45-degree field of view. 2352x1568
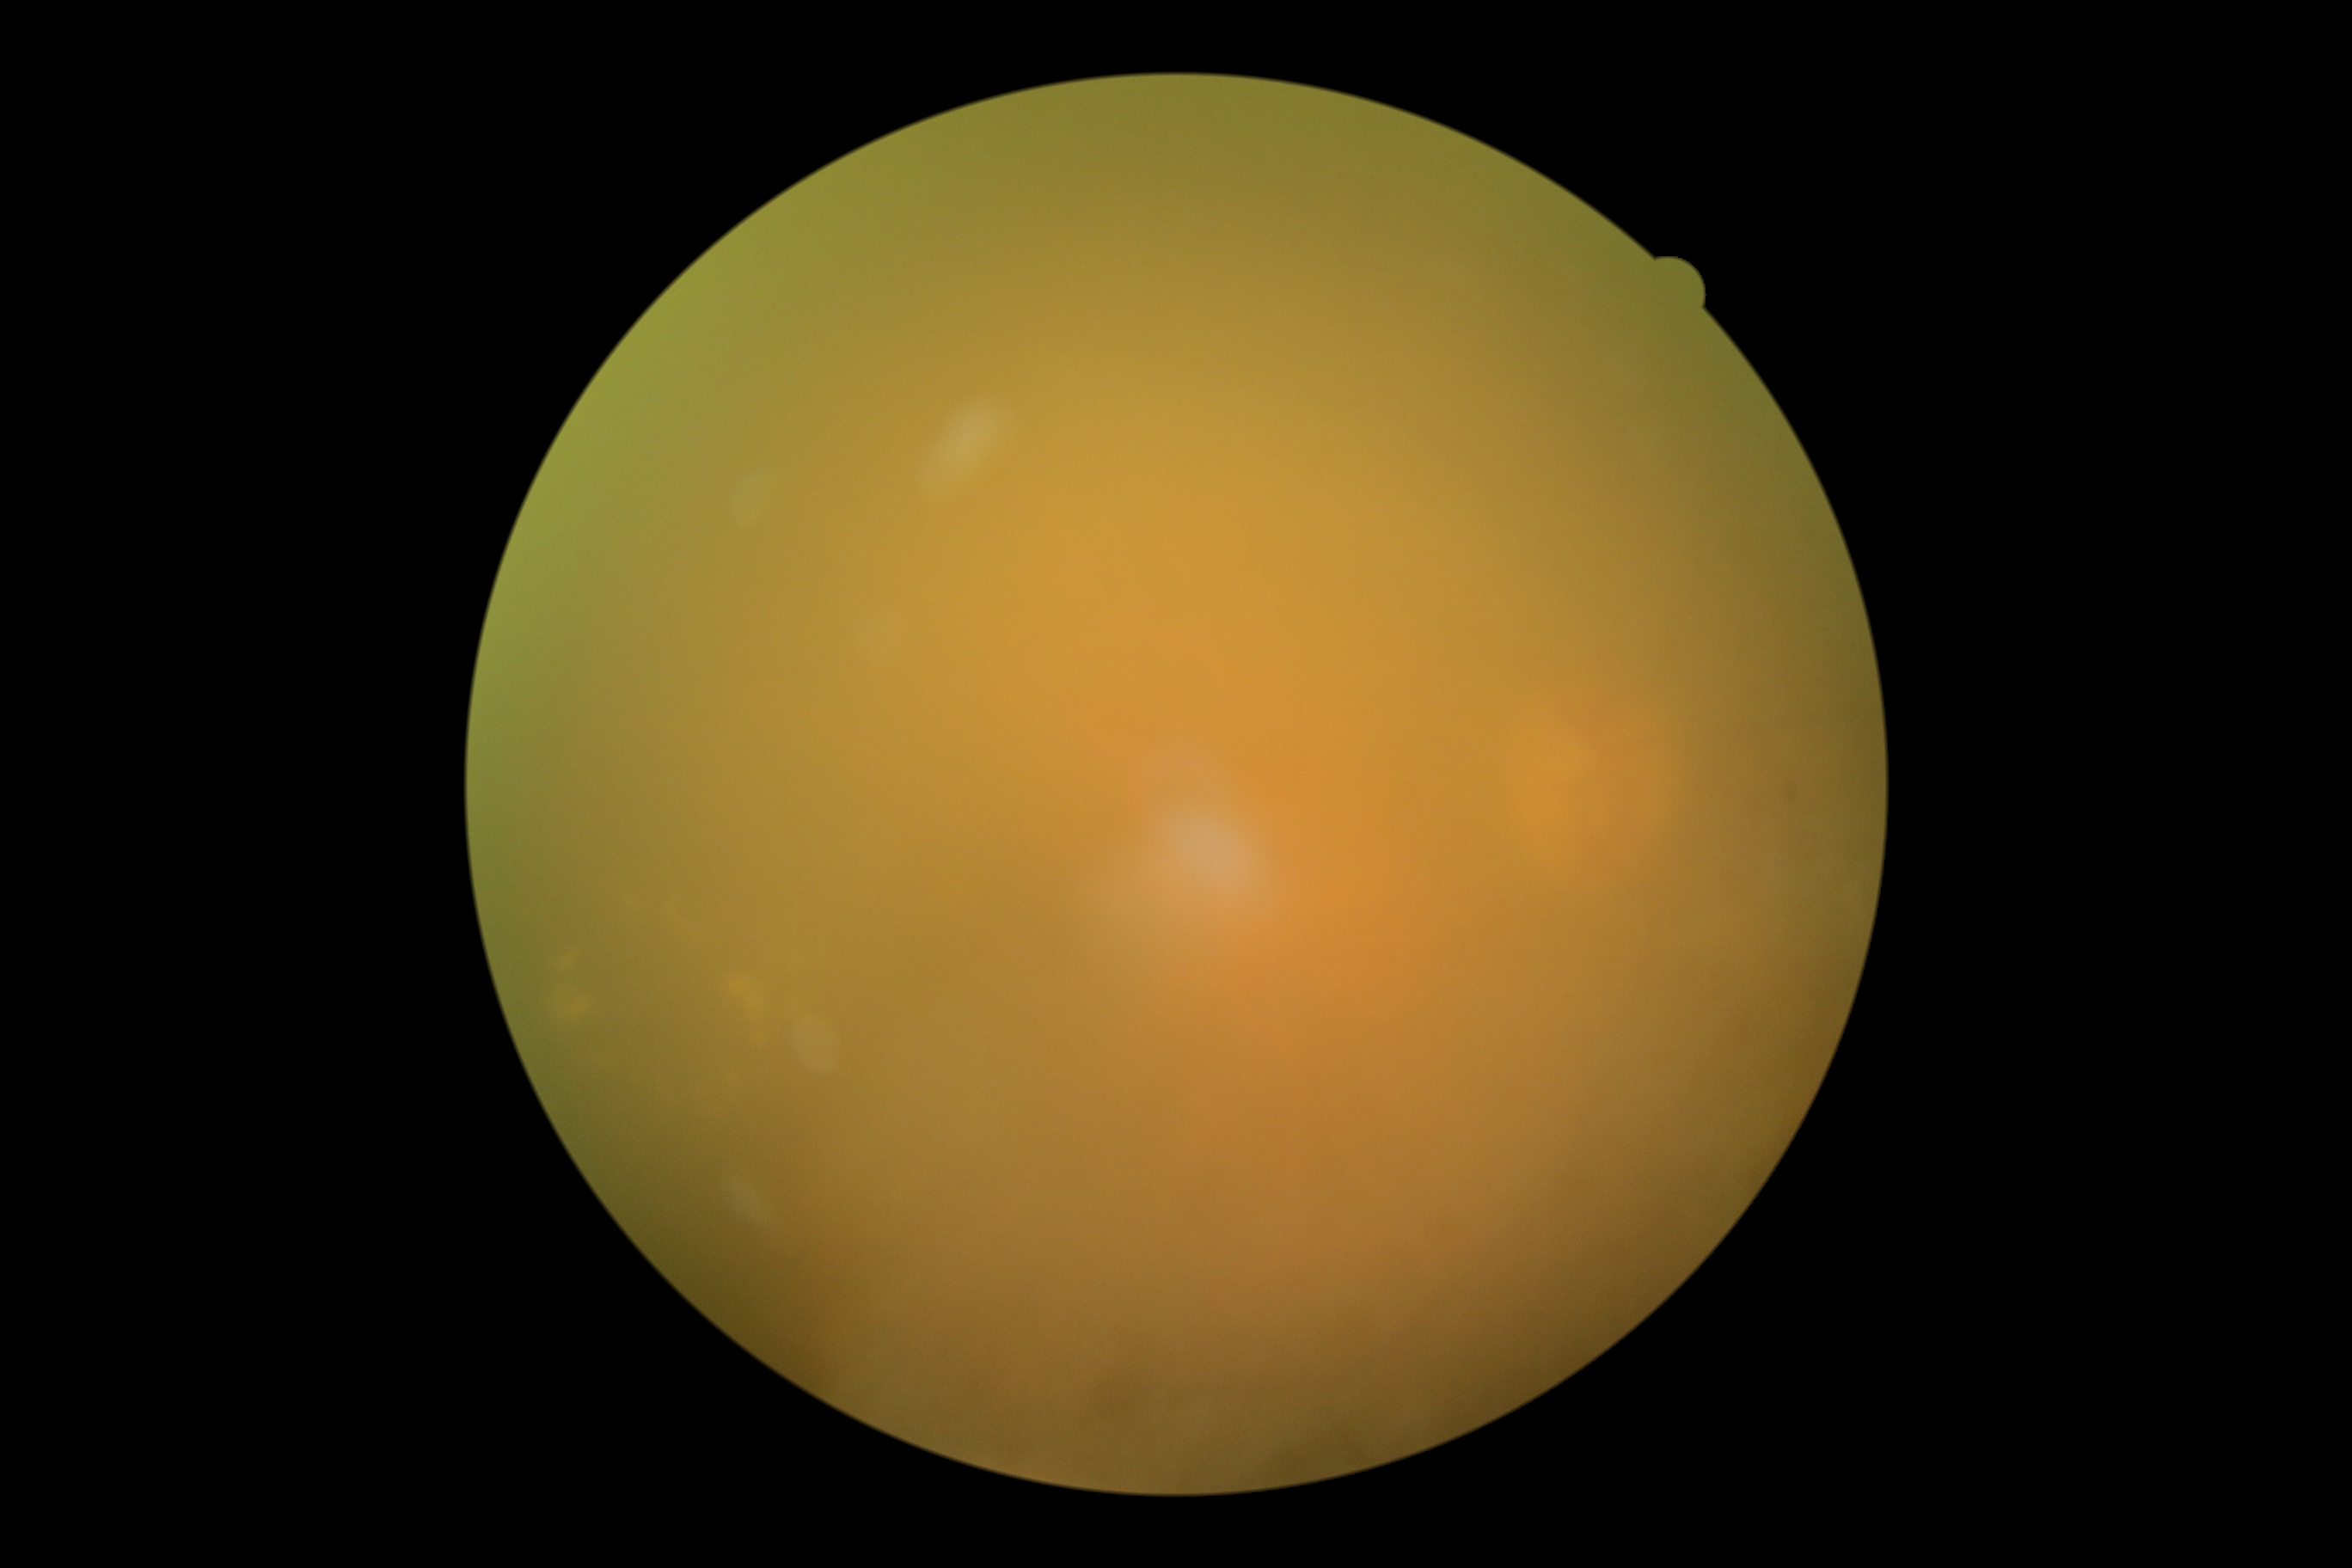
DR severity: ungradable. The image cannot be graded for diabetic retinopathy.